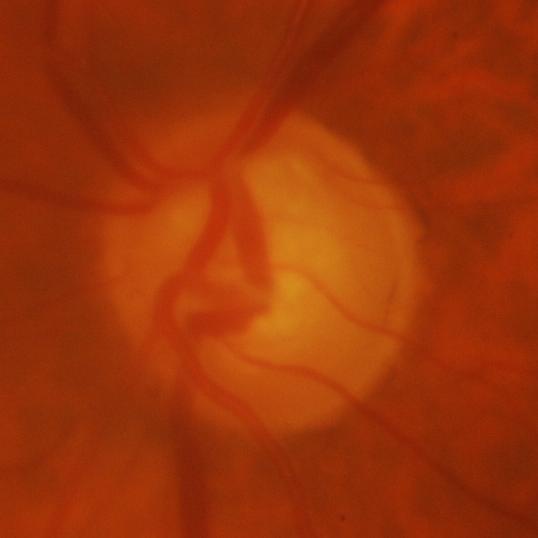

Glaucomatous findings.